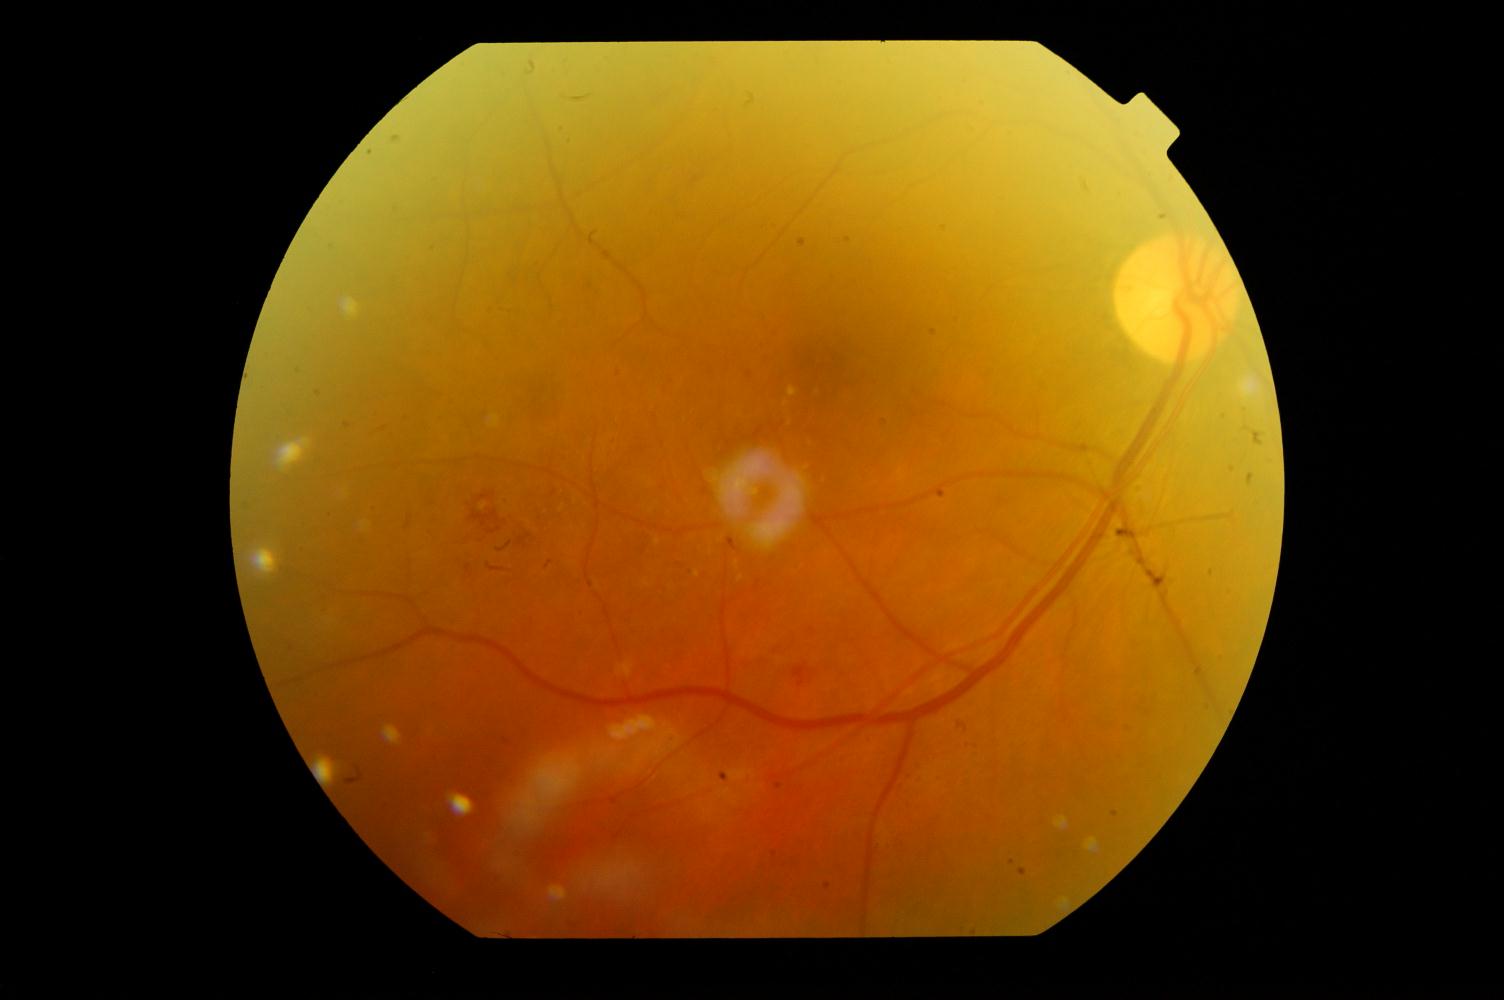
Findings consistent with diabetic retinopathy.